Color fundus image.
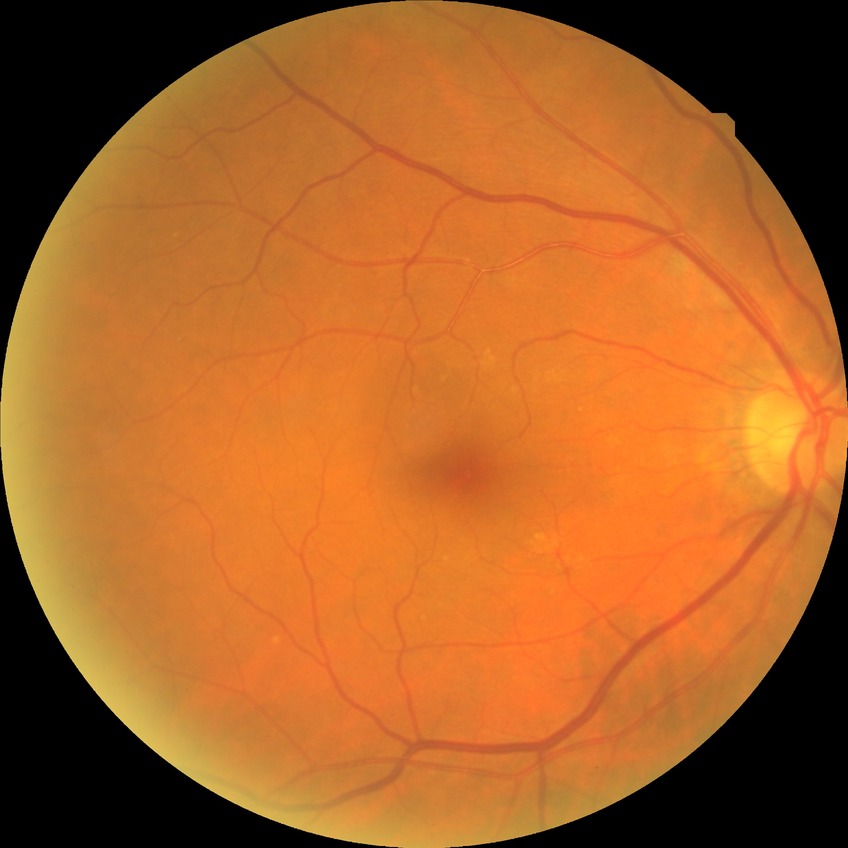
Annotations:
* diabetic retinopathy (DR) — NDR (no diabetic retinopathy)